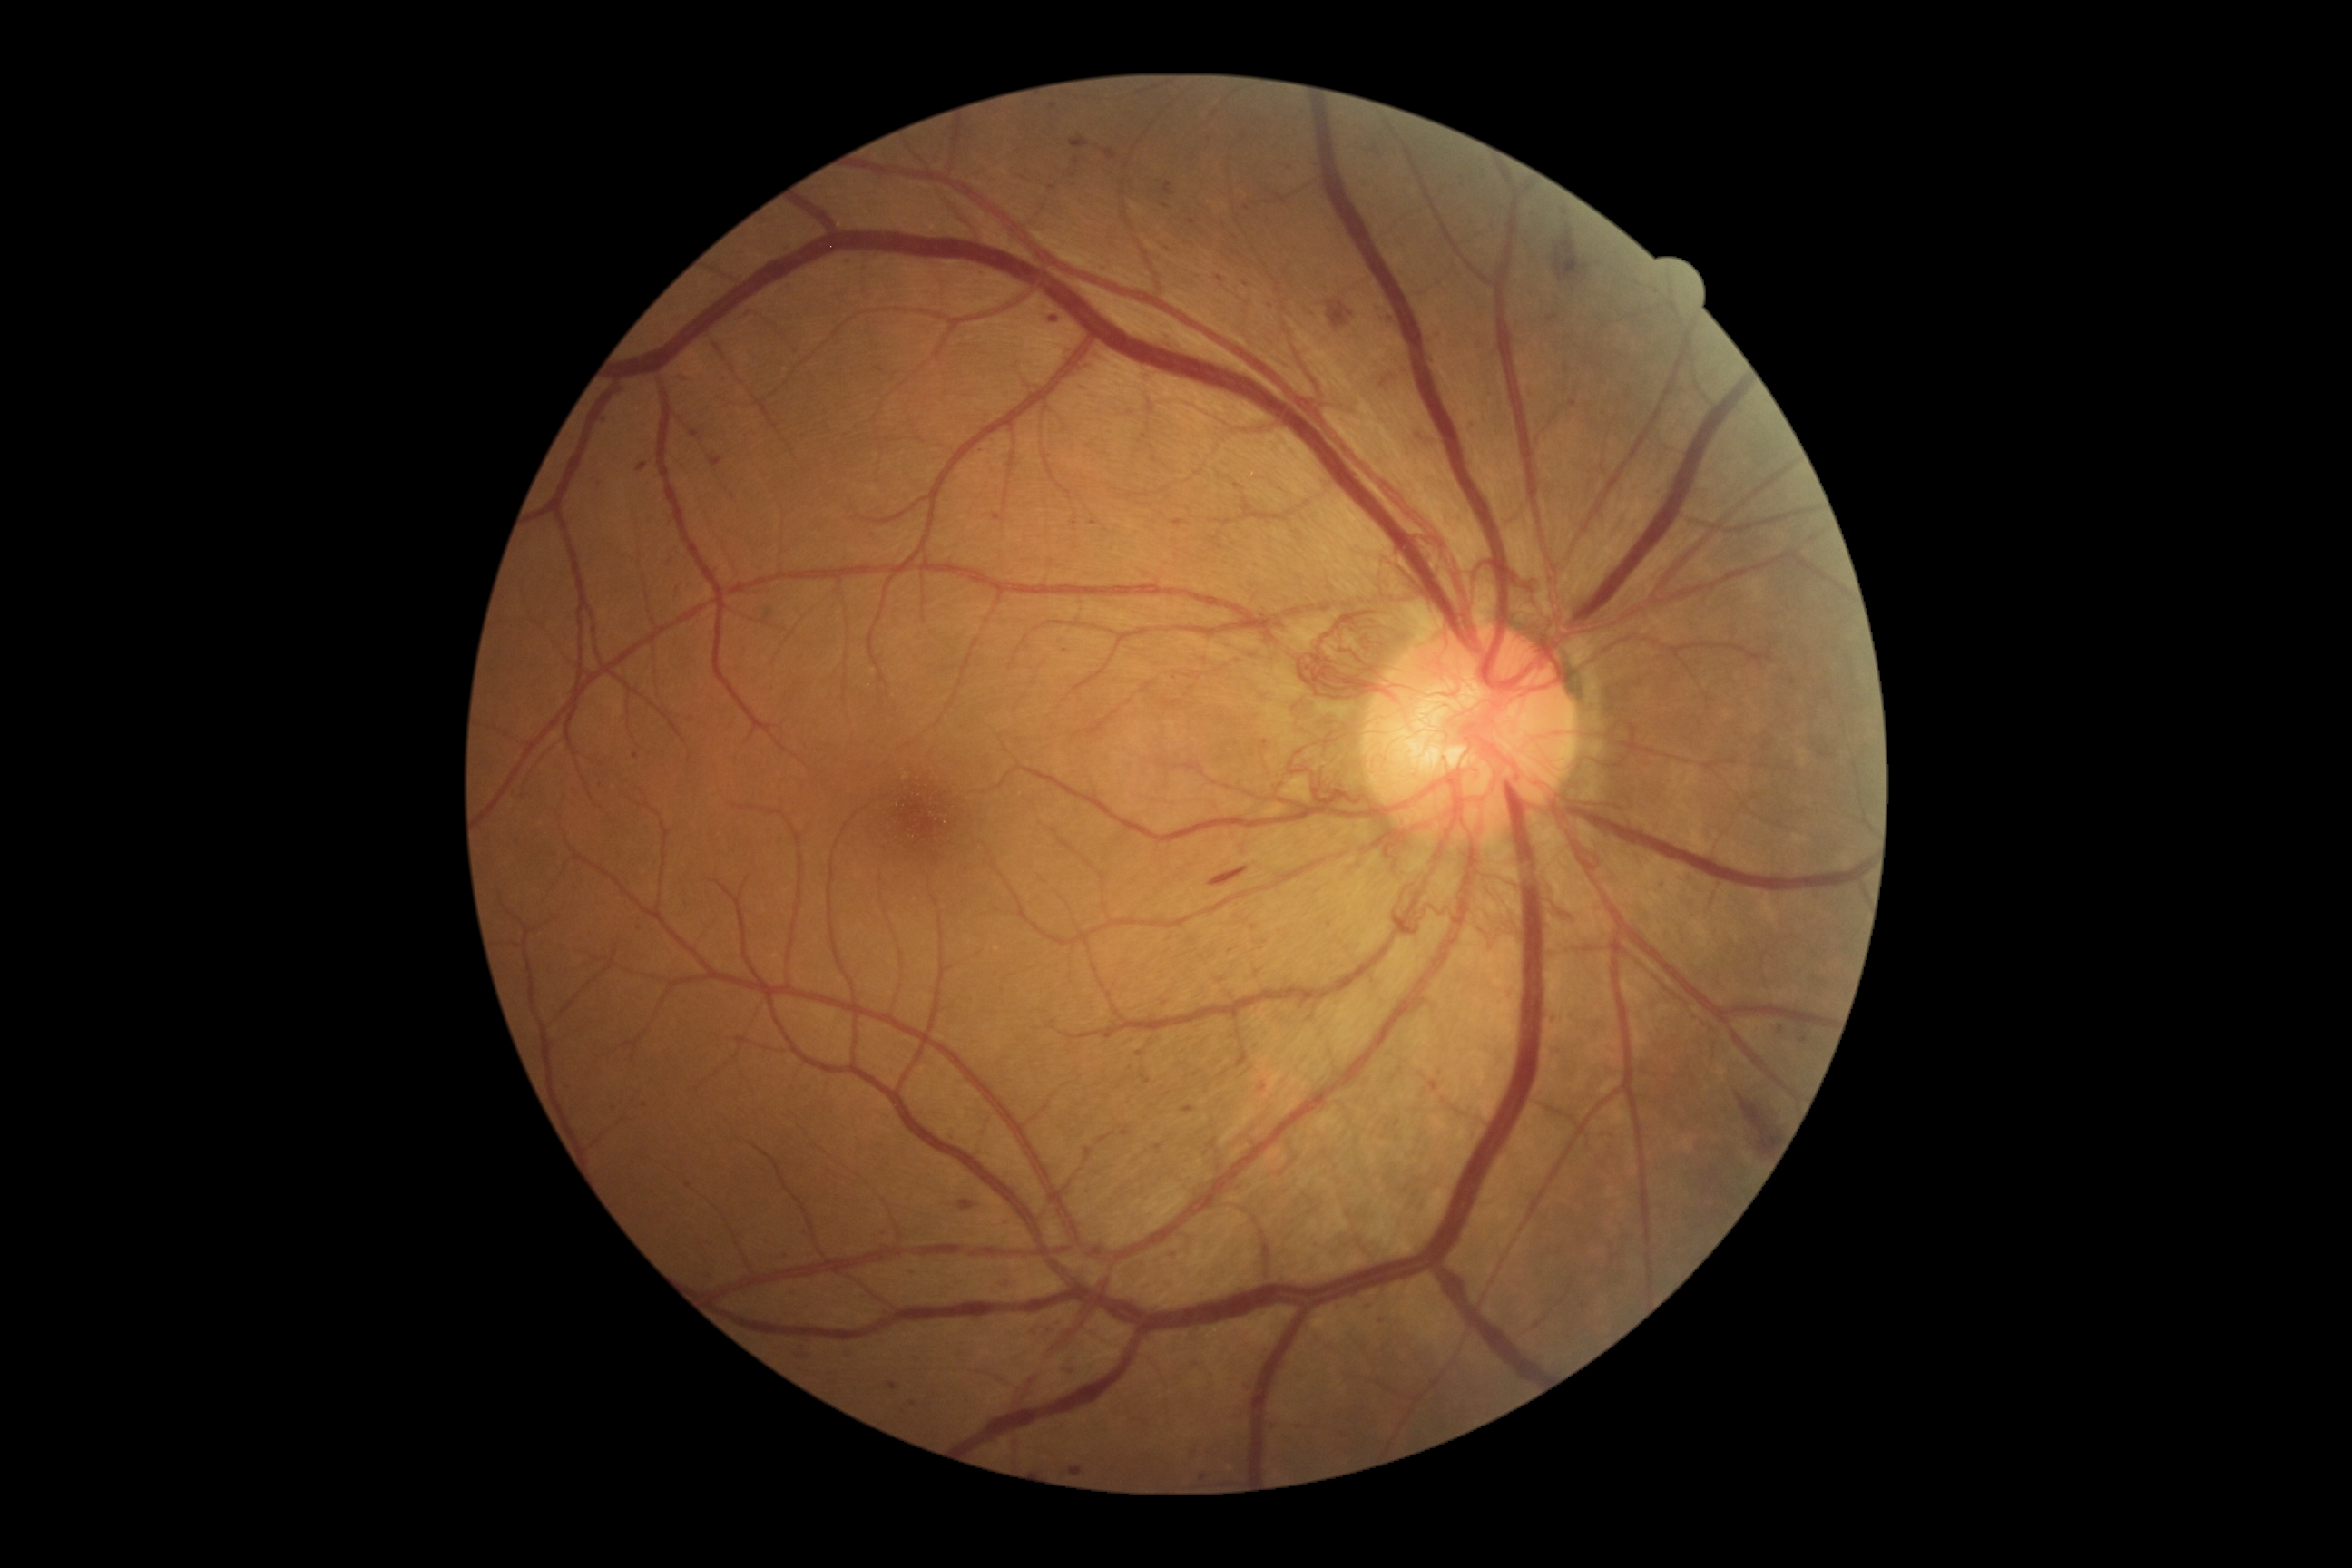

Retinopathy grade is 4 (PDR)
Representative lesions:
* microaneurysms (subset): rect(691, 431, 700, 438); rect(1551, 1015, 1556, 1023); rect(1073, 157, 1079, 166); rect(714, 456, 720, 467); rect(1375, 306, 1386, 315); rect(1242, 1378, 1251, 1386); rect(1661, 881, 1667, 890); rect(1260, 1084, 1266, 1092)
* Additional small microaneurysms near x=644 y=1104; x=1140 y=1054; x=849 y=262; x=640 y=930; x=1247 y=208; x=1094 y=522; x=1232 y=952; x=747 y=312; x=1266 y=743; x=727 y=378; x=1073 y=521